Without pupil dilation. Posterior pole color fundus photograph: 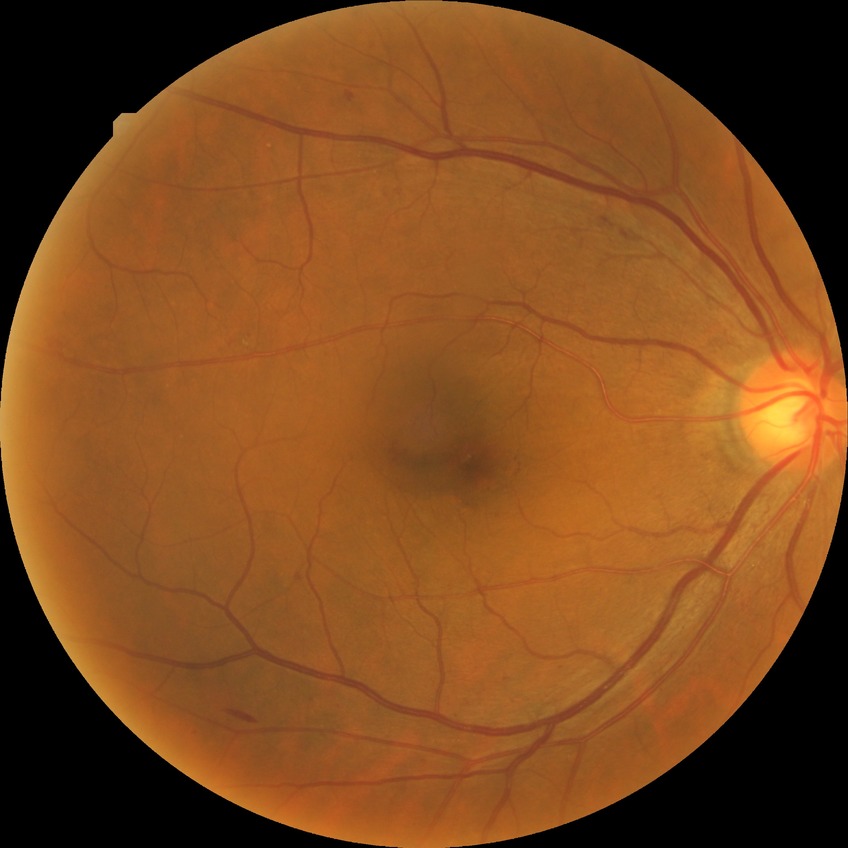 diabetic retinopathy (DR) = pre-proliferative diabetic retinopathy (PPDR).